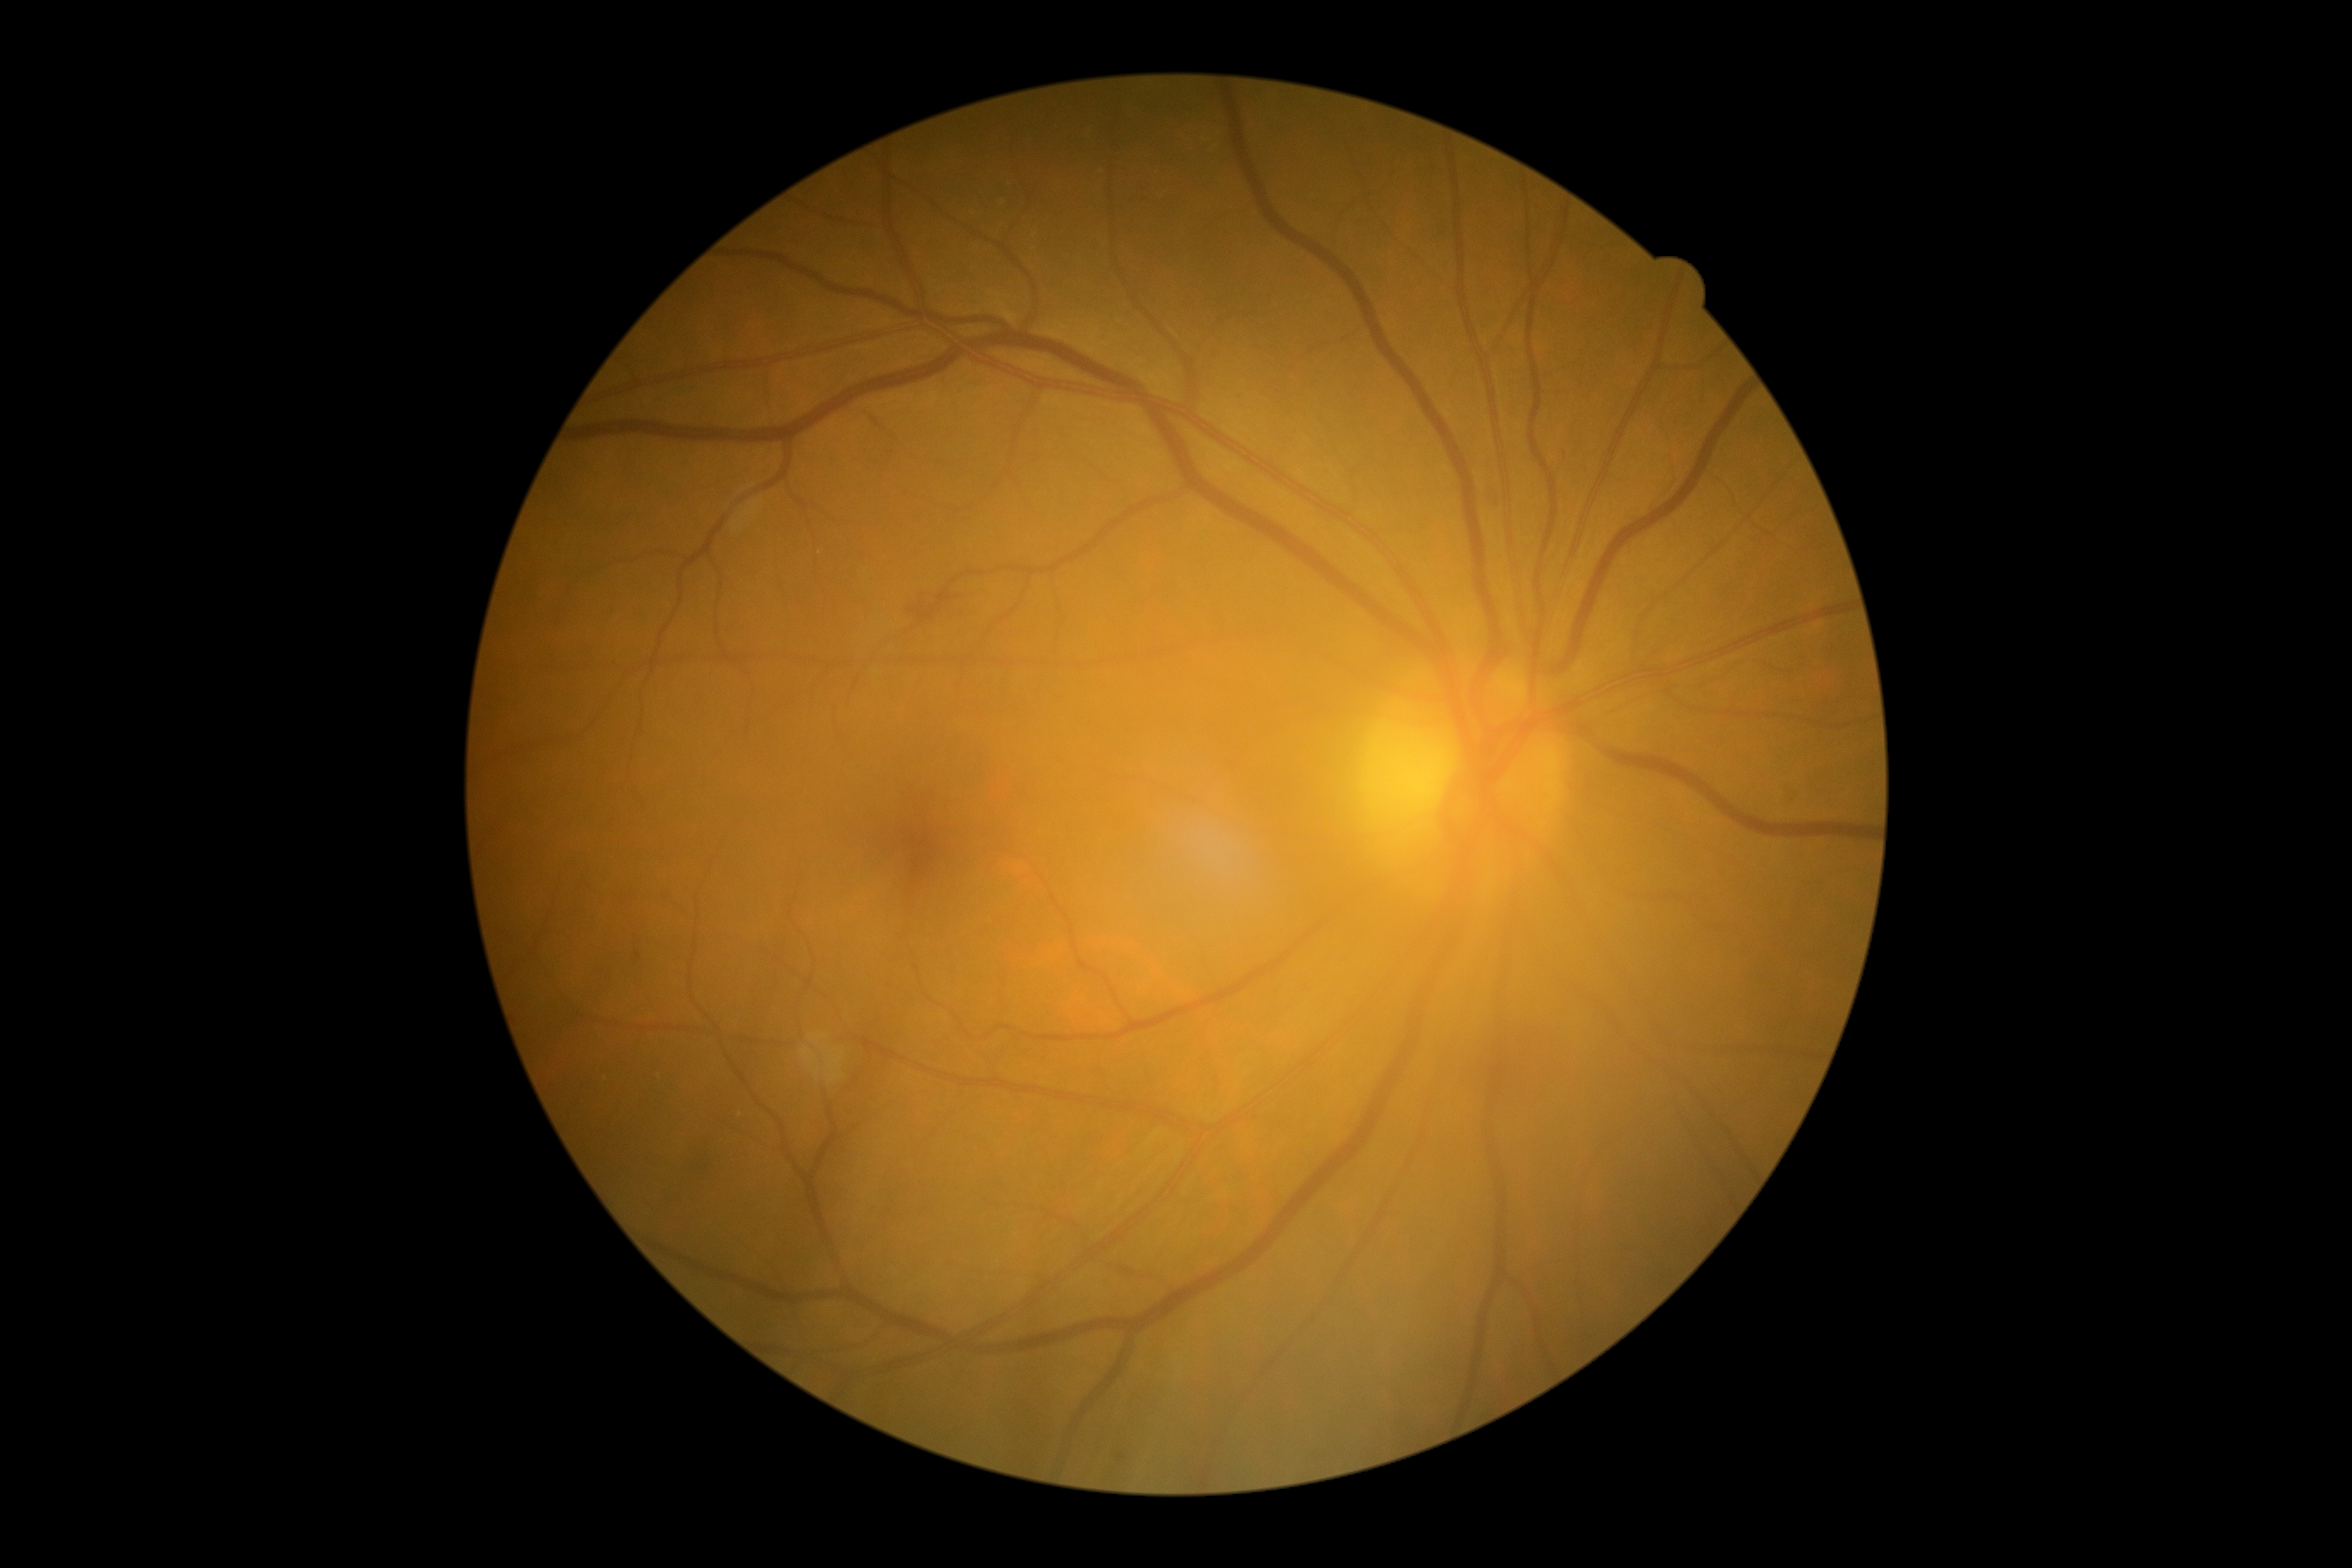

DR is 2/4; non-proliferative diabetic retinopathy. No EXs identified. HEs identified at [912,594,959,613]. No MAs identified. No SEs identified.